Image size 848x848; 45 degree fundus photograph:
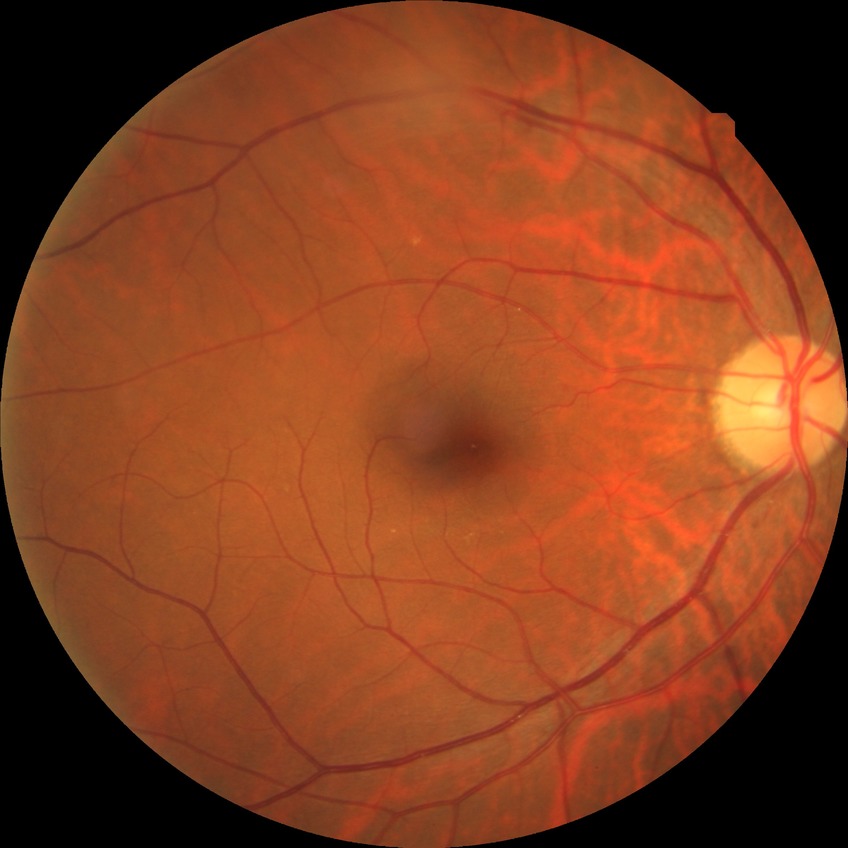

  davis_grade: no diabetic retinopathy